1525 by 1280 pixels · 45-degree field of view.
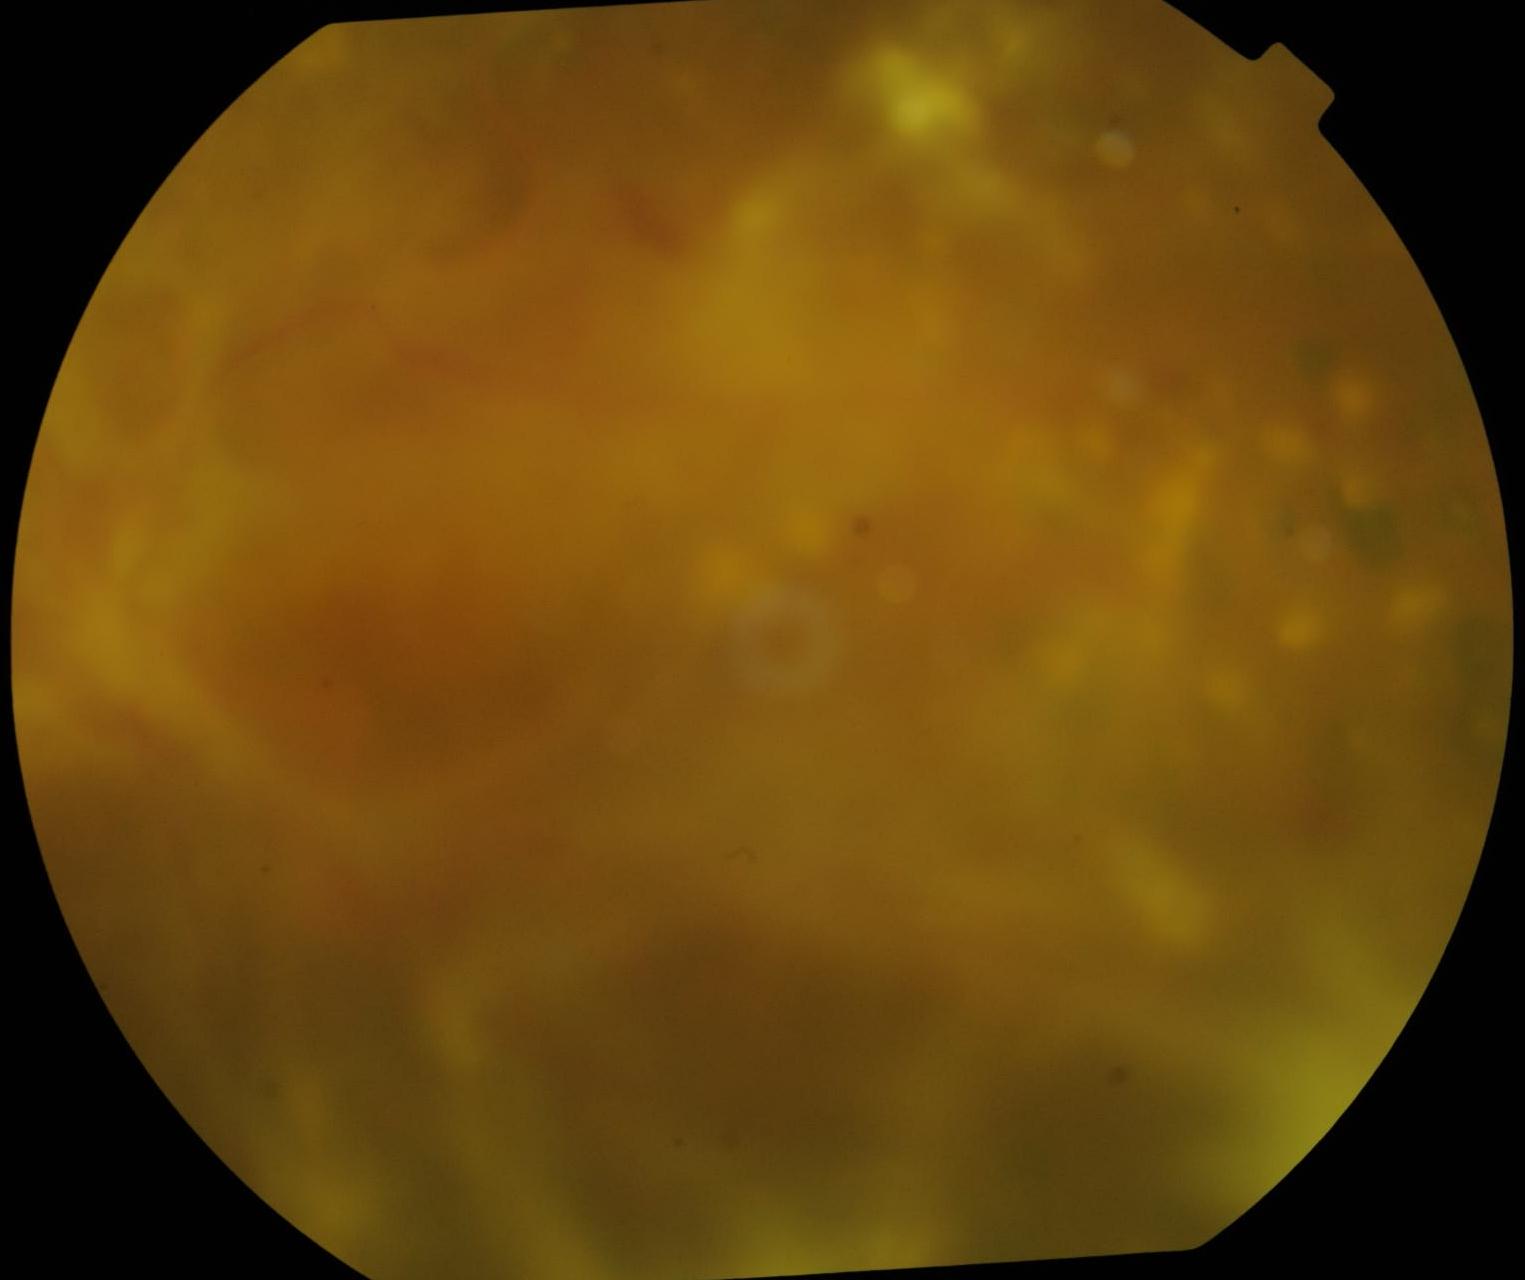 DR severity: grade 4.